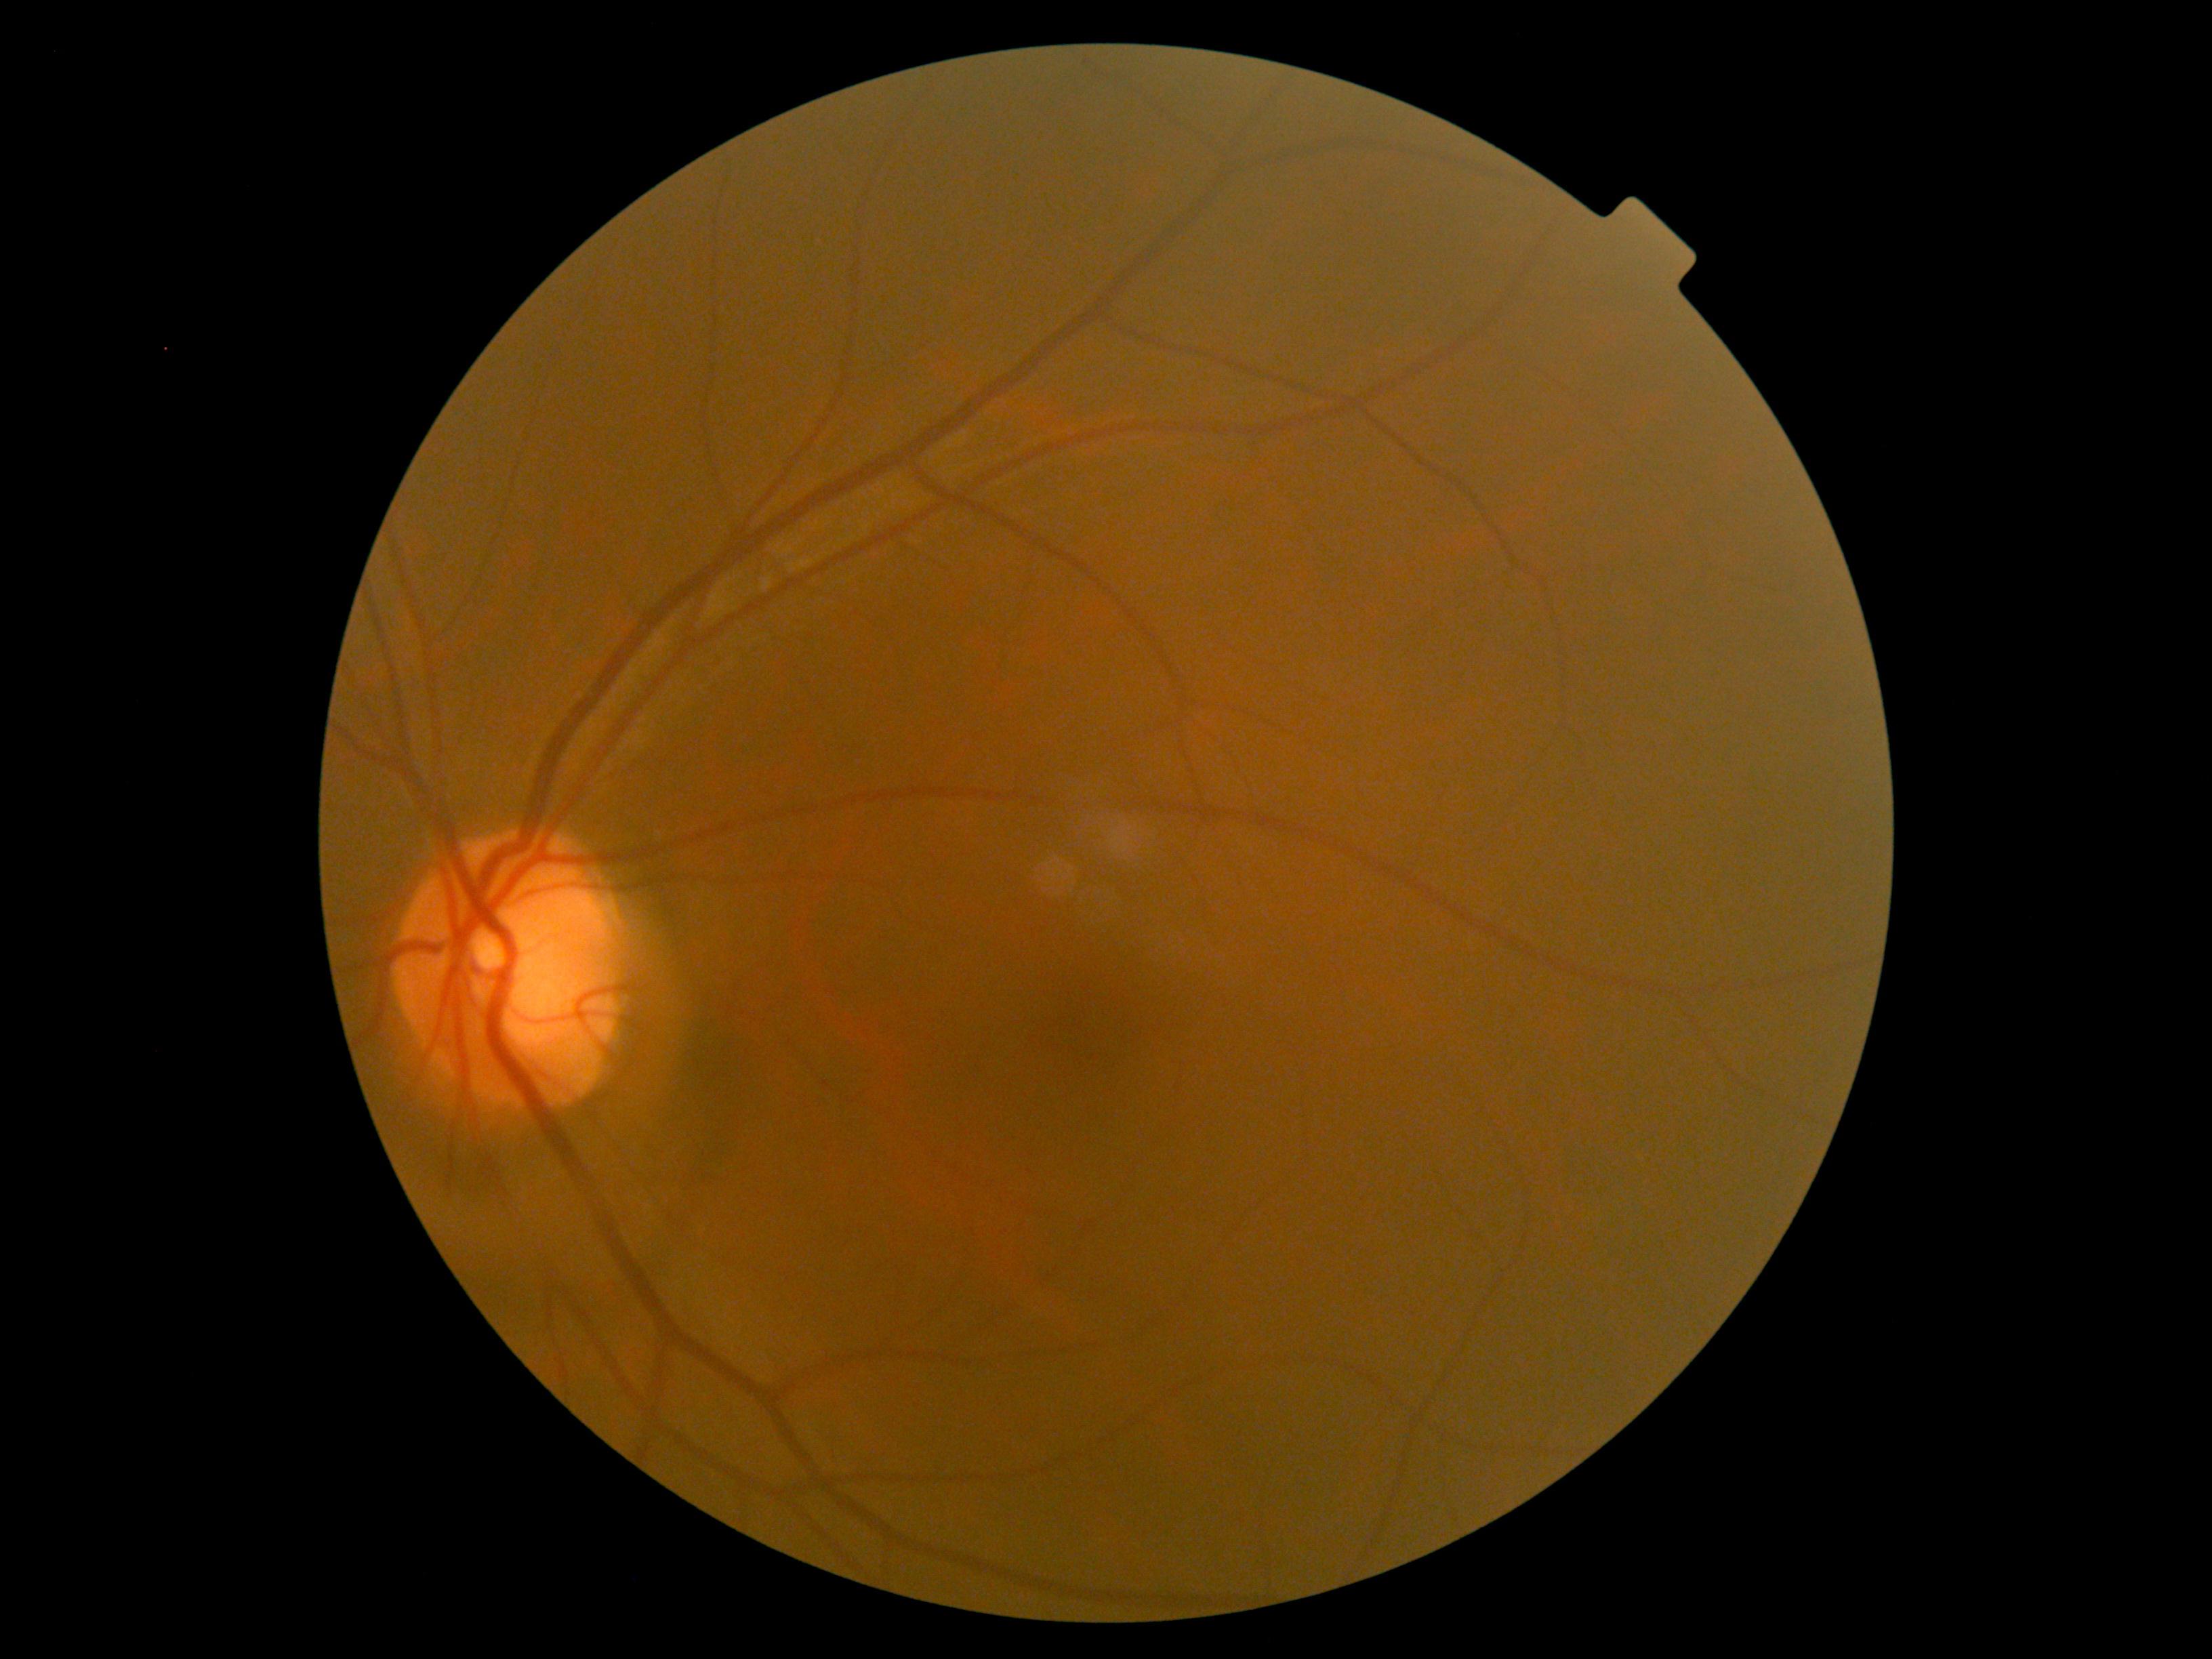
{"dr_grade": "grade 0"}